2346x1568:
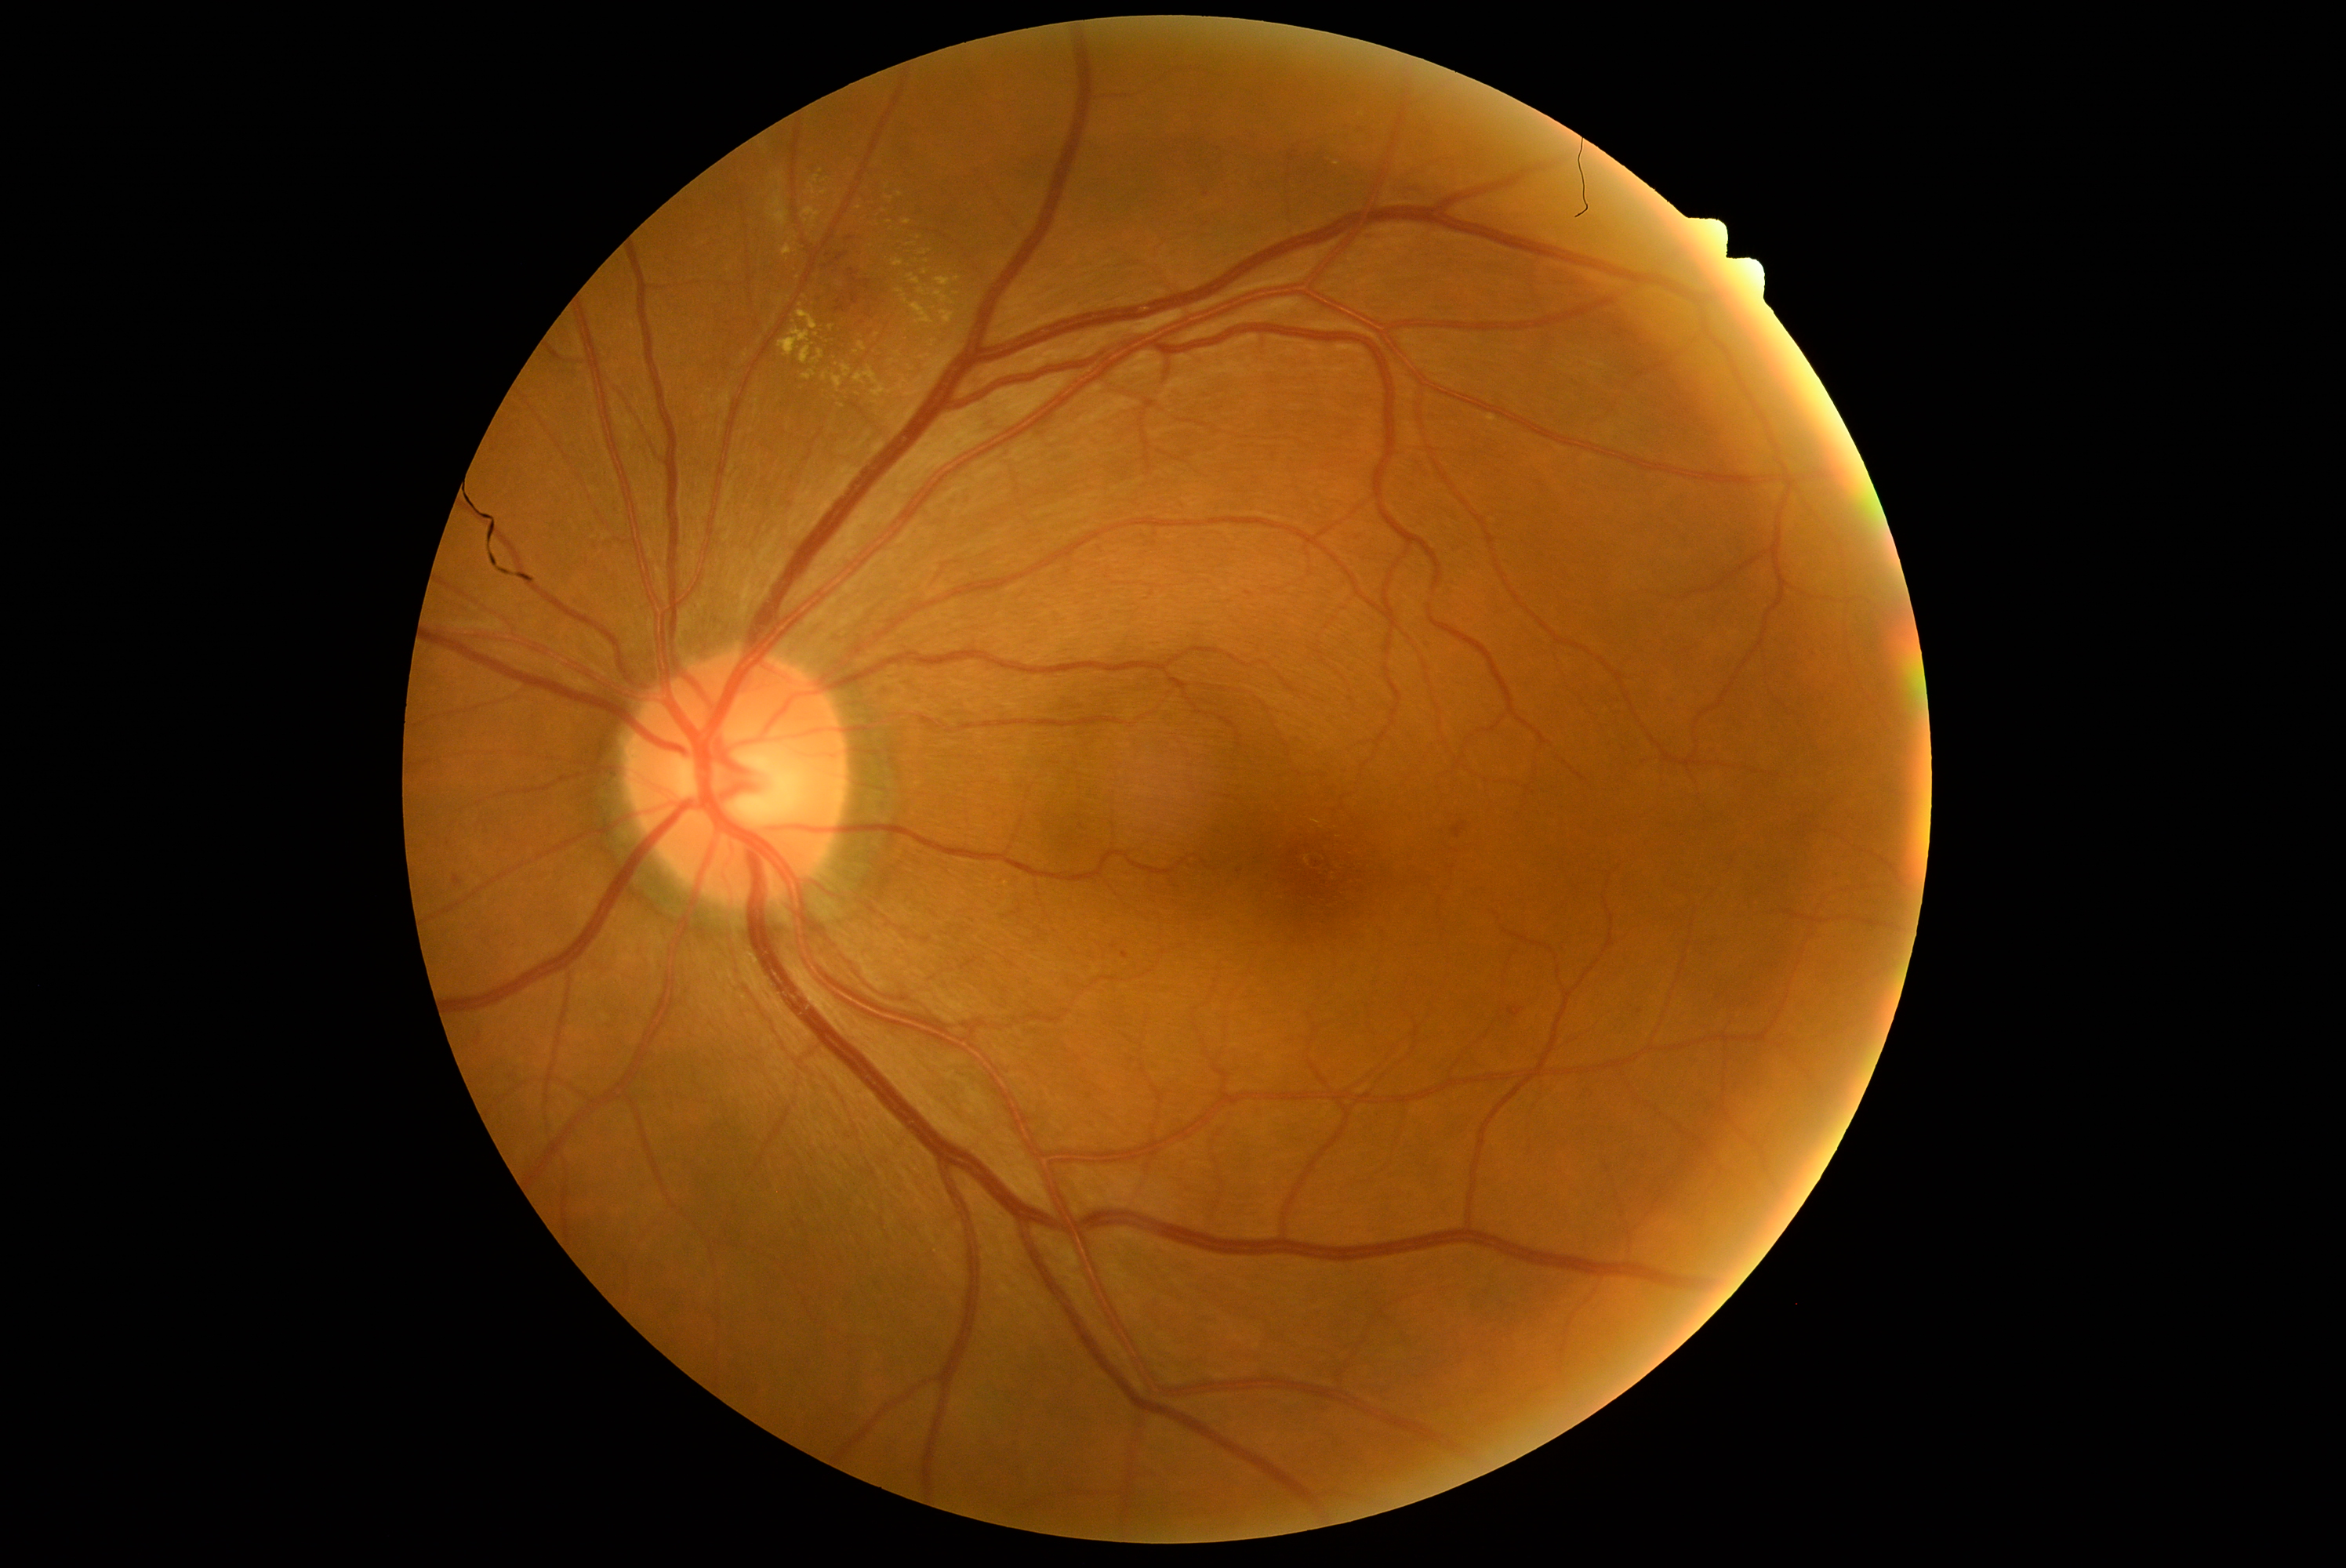
Diabetic retinopathy (DR): grade 2 (moderate NPDR)
A subset of detected lesions:
hemorrhages (HEs) (more not shown): Rect(1334, 194, 1348, 198), Rect(1508, 1007, 1523, 1018), Rect(1392, 178, 1429, 201), Rect(1453, 822, 1467, 838), Rect(1342, 123, 1353, 131), Rect(1807, 647, 1818, 659)
Smaller HEs around <point>1207, 225</point>, <point>1641, 1012</point>, <point>1207, 196</point>, <point>1219, 149</point>, <point>478, 1044</point>
hard exudates (EXs) (more not shown): Rect(841, 365, 852, 379), Rect(779, 328, 813, 365), Rect(902, 220, 912, 227), Rect(808, 184, 816, 195), Rect(907, 274, 921, 286), Rect(934, 291, 954, 305), Rect(796, 311, 819, 332), Rect(926, 339, 939, 349), Rect(896, 289, 904, 294), Rect(920, 250, 931, 256)
Smaller EXs around <point>806, 221</point>, <point>1316, 823</point>, <point>781, 300</point>, <point>889, 223</point>, <point>842, 406</point>, <point>898, 355</point>, <point>1362, 115</point>, <point>925, 272</point>